Non-mydriatic acquisition:
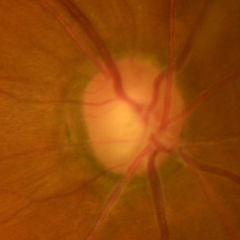

Assessment: early glaucoma.